Disc-centered field
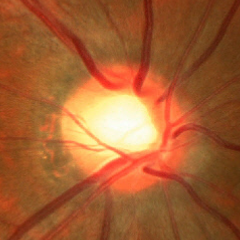 Q: Does this eye have glaucoma?
A: No — no glaucoma.